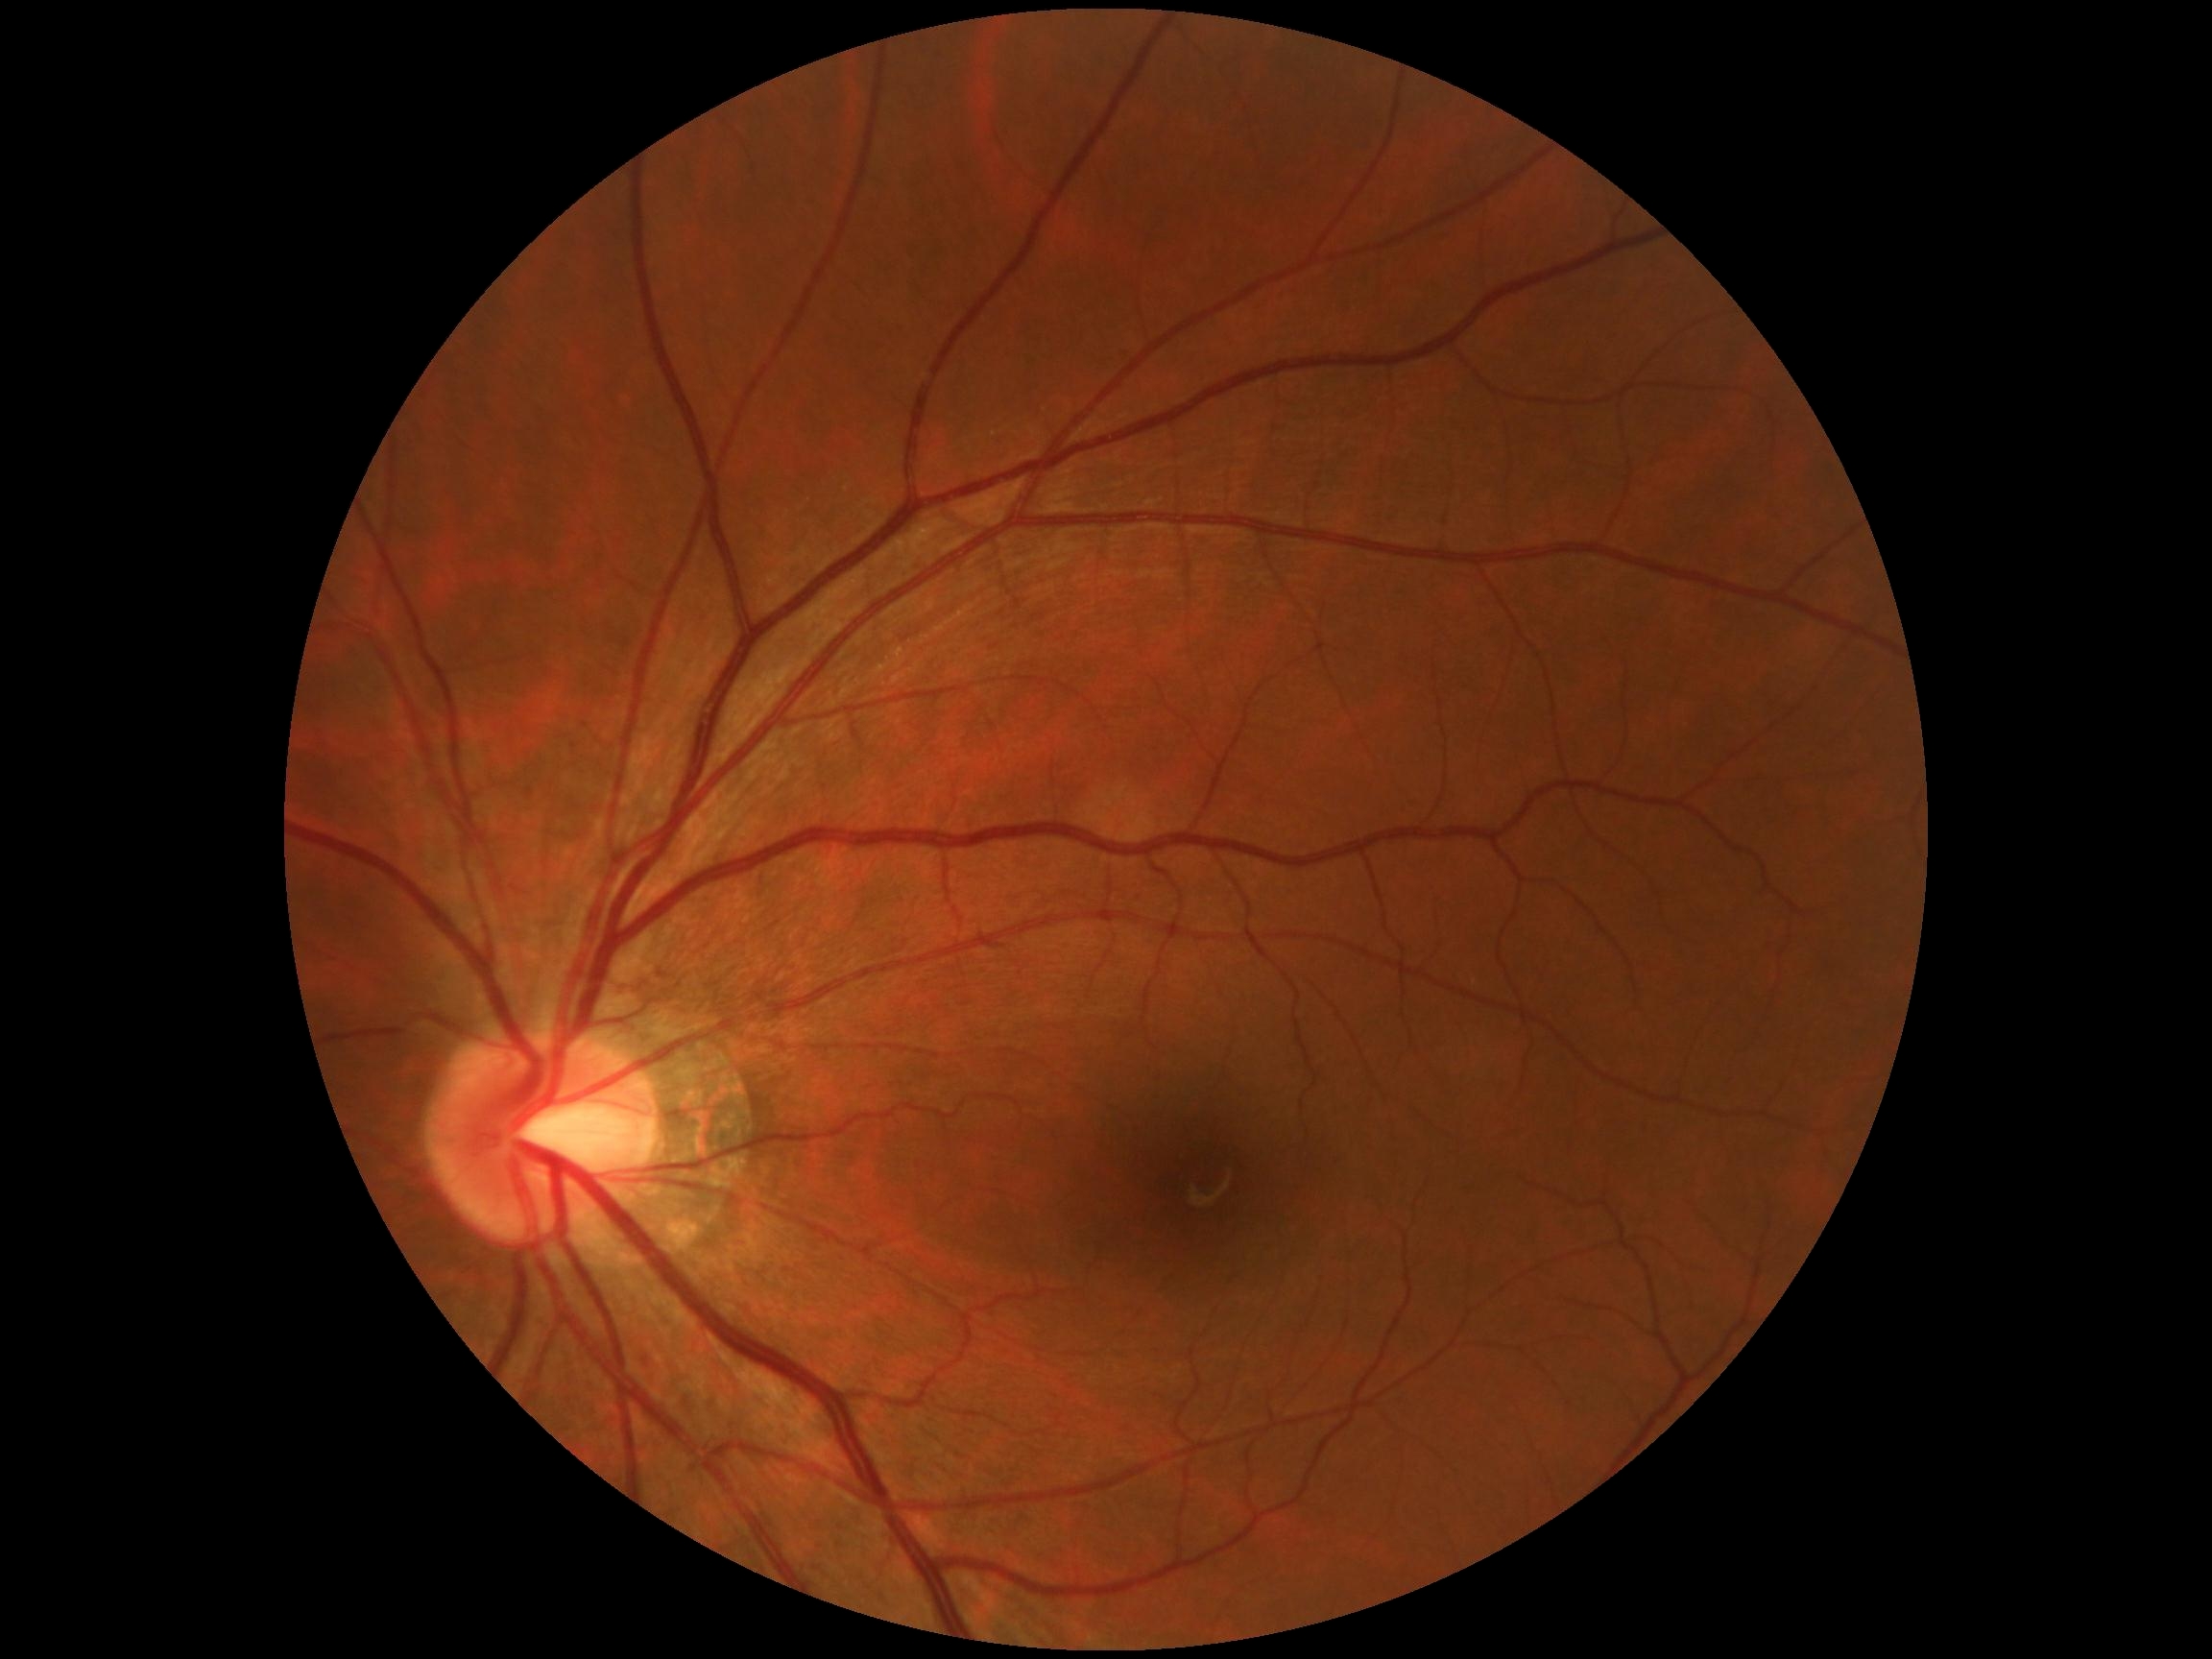 DR severity is 0.